Fundus photo — 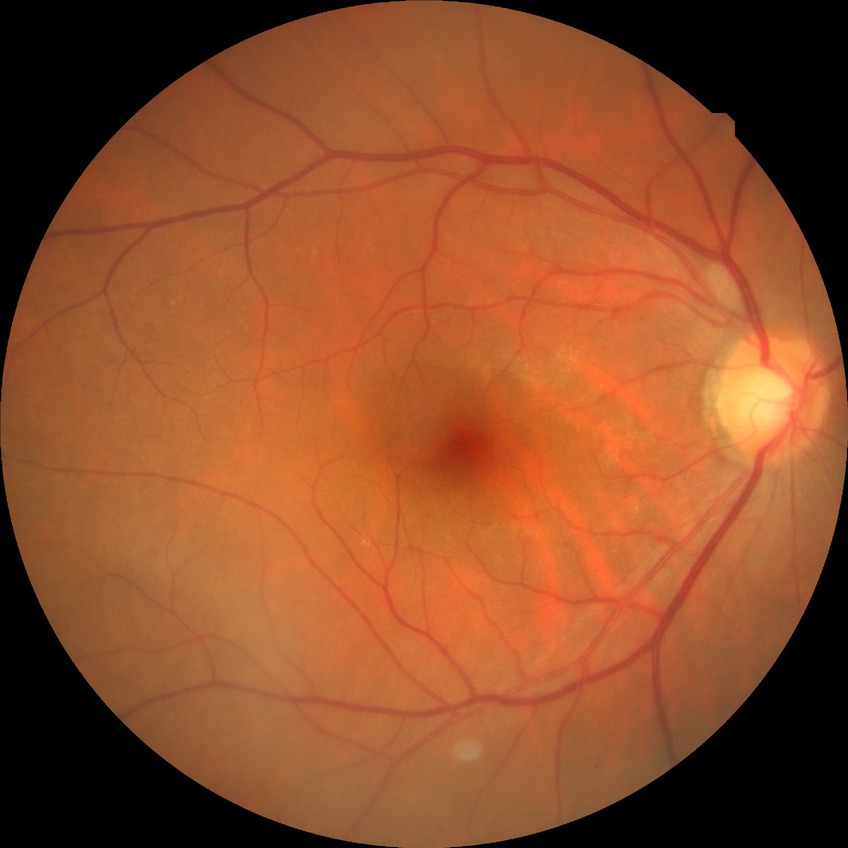

Diabetic retinopathy severity: no diabetic retinopathy.